Wide-field fundus photograph from neonatal ROP screening. Camera: Clarity RetCam 3 (130° FOV). 640x480px
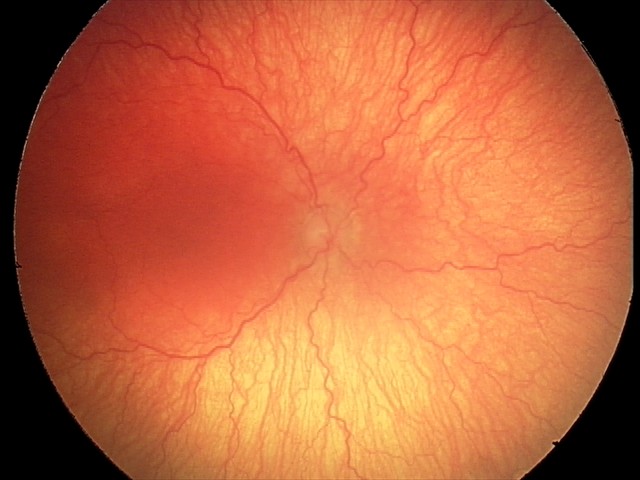

Q: What is the diagnosis from this examination?
A: A-ROP (aggressive ROP) — rapidly progressive severe ROP with prominent plus disease, often without classic stage progression